Nonmydriatic fundus photograph: 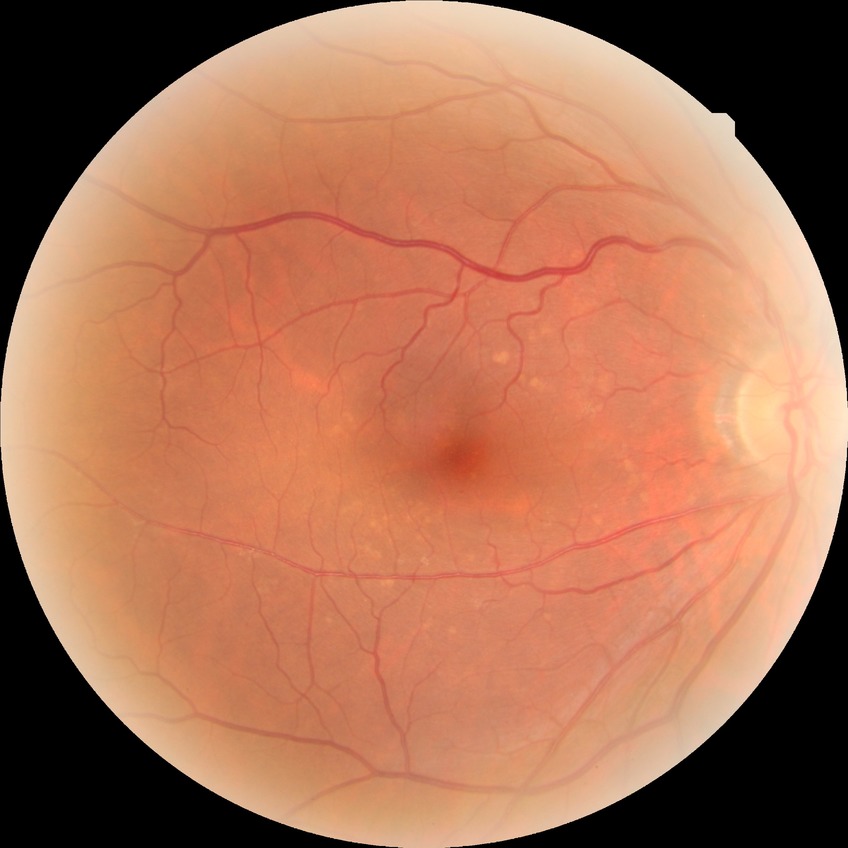

Davis stage: NDR.